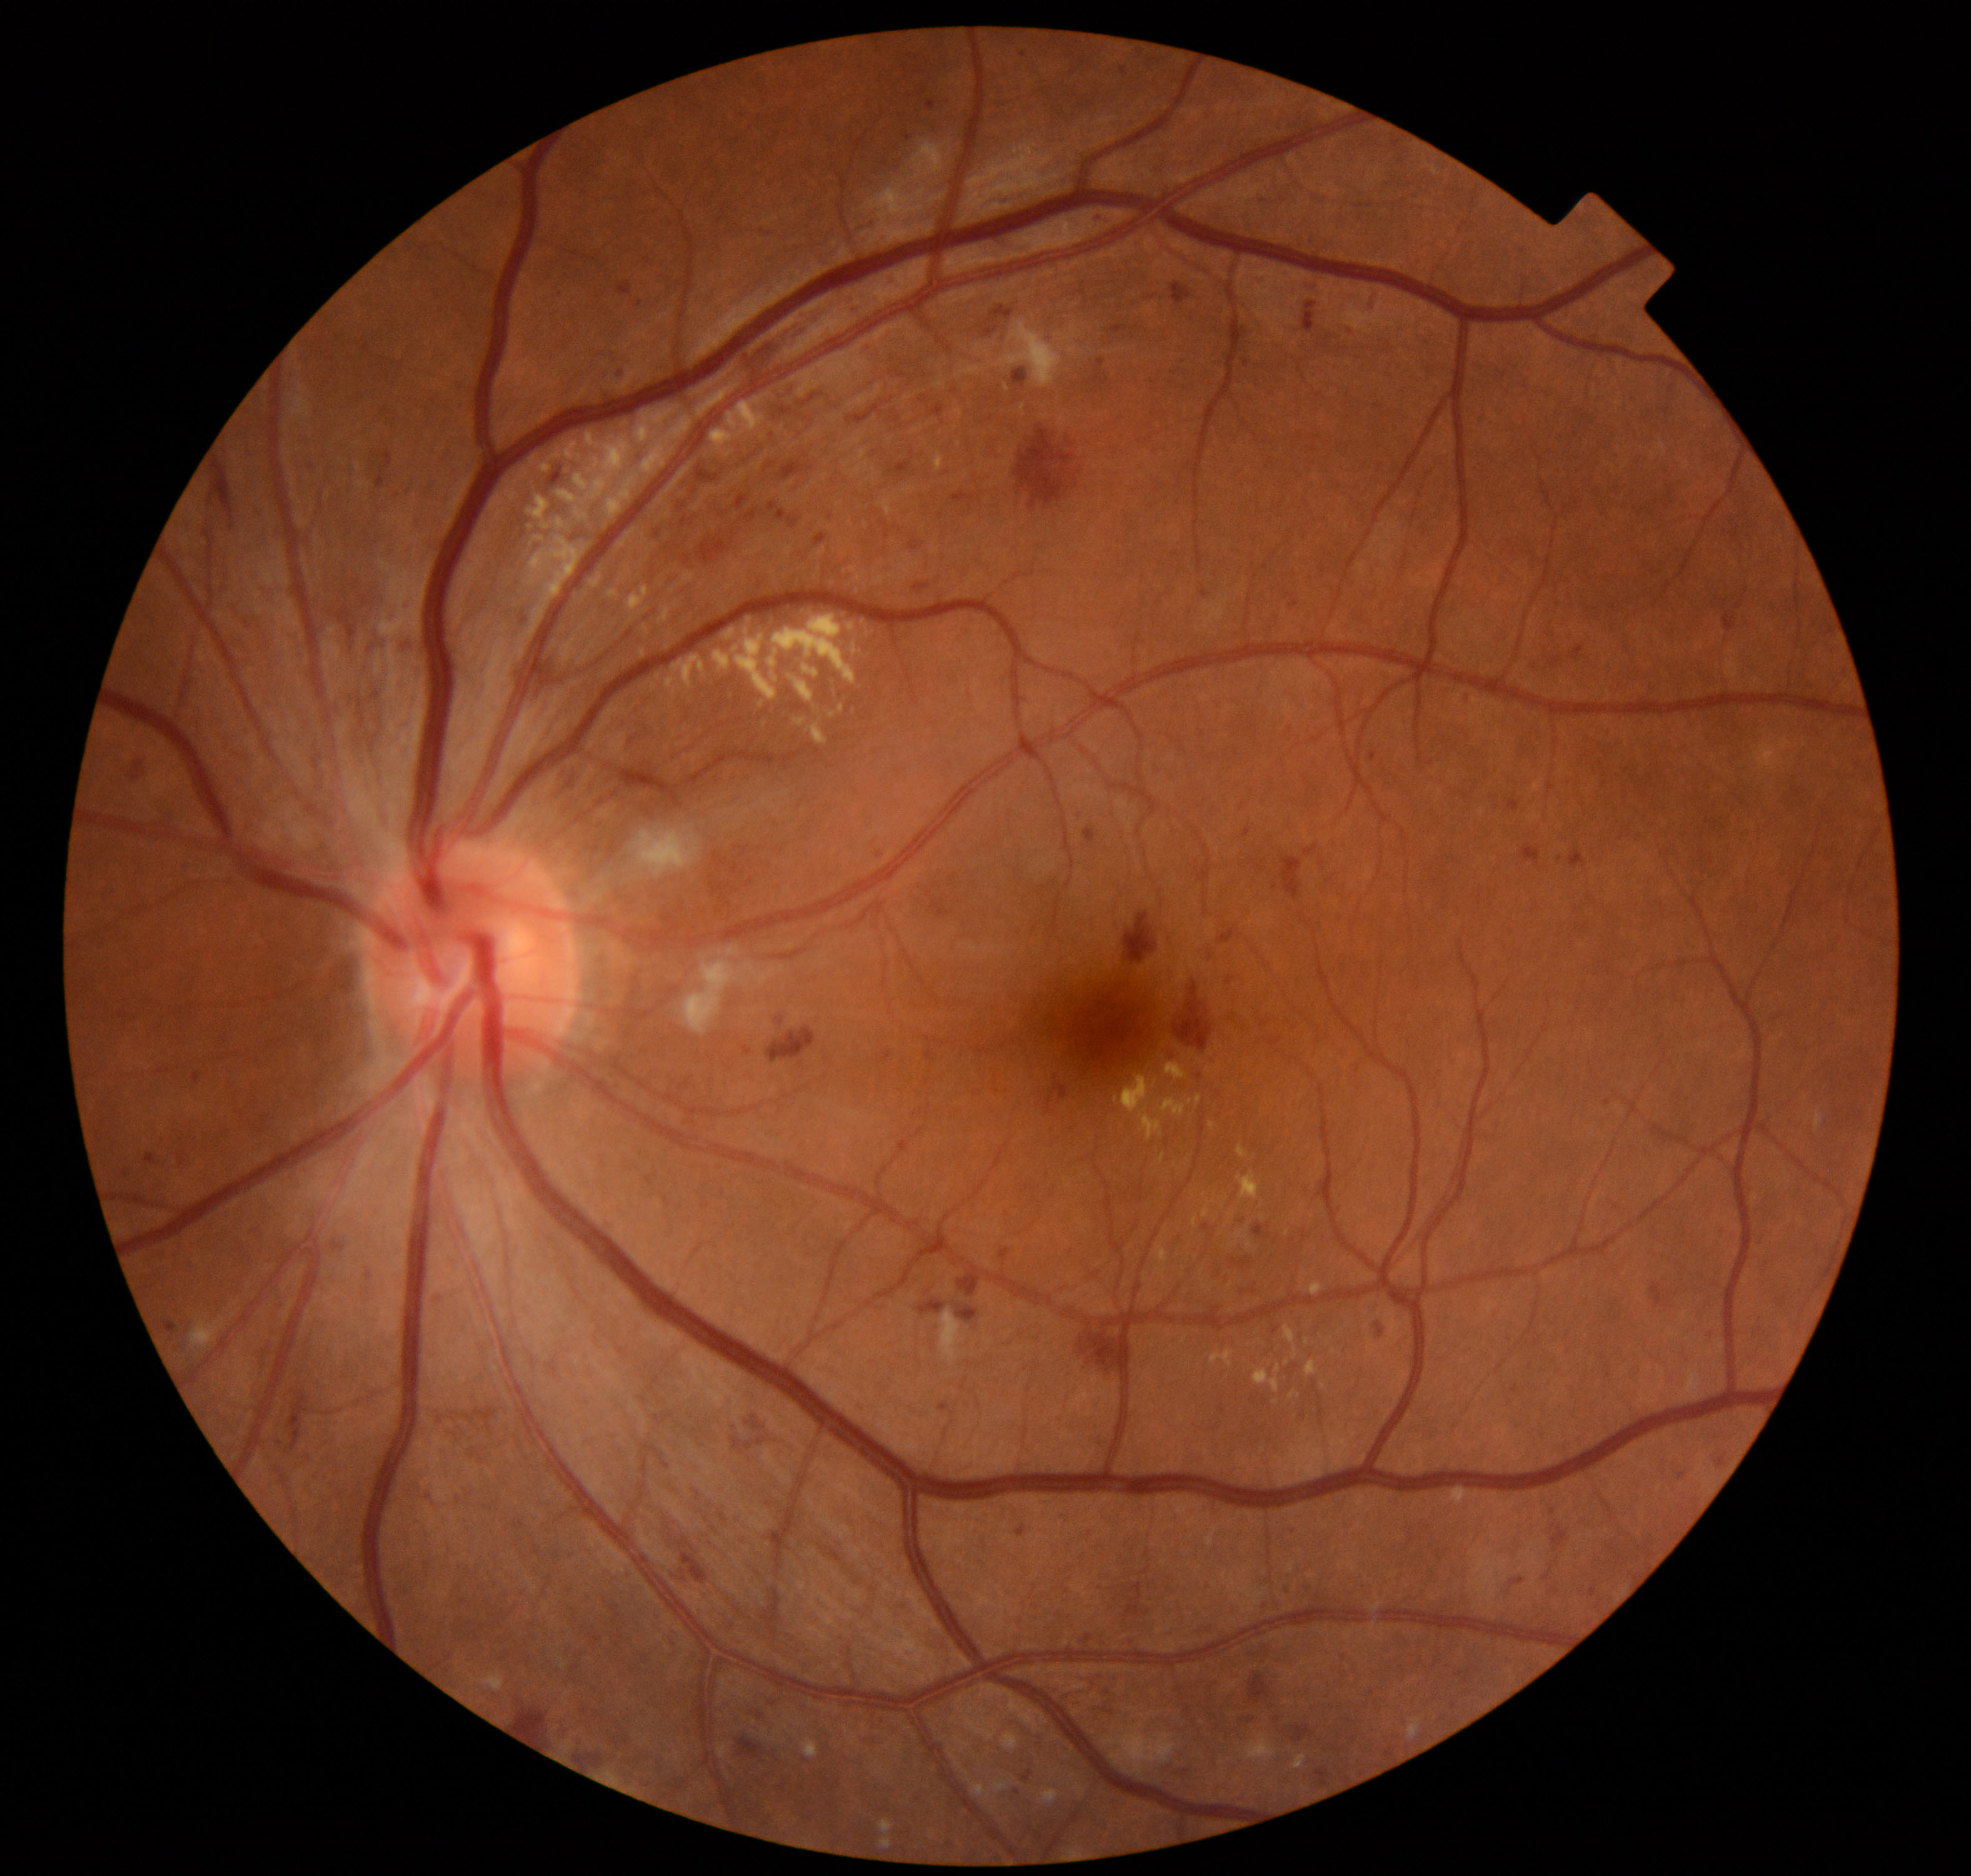

Demonstrates moderate non-proliferative diabetic retinopathy.